1240x1240px. Phoenix ICON wide-field infant fundus image. Phoenix ICON, 100° FOV: 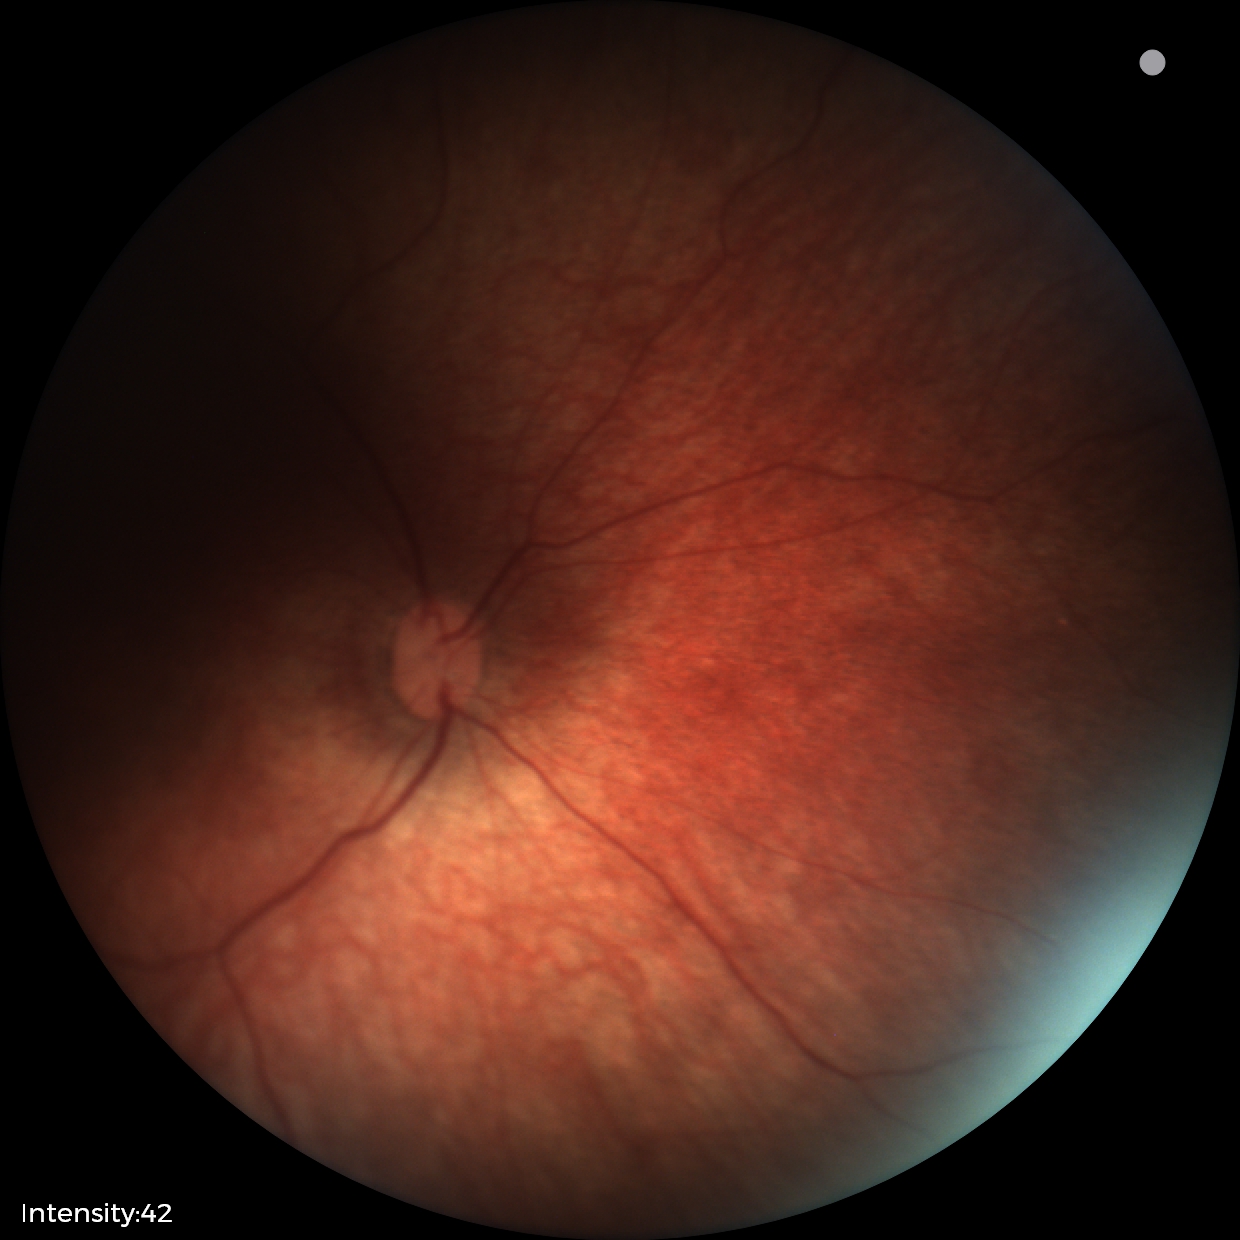 Q: What was the screening finding?
A: physiological appearance with no retinal pathology